45° FOV
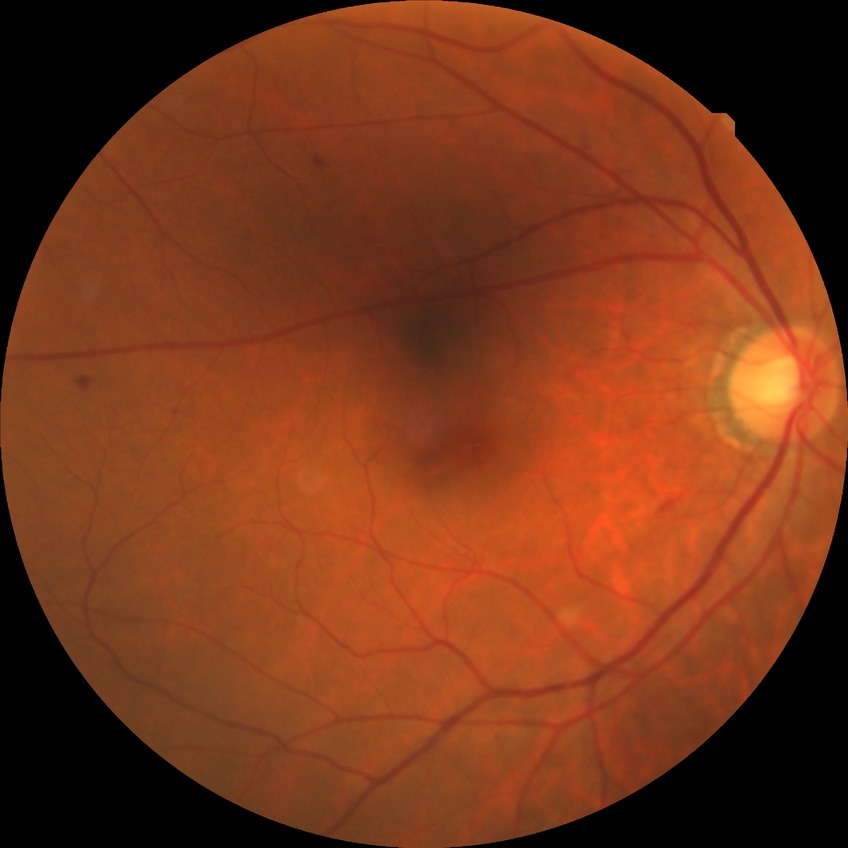

Diabetic retinopathy (DR) is simple diabetic retinopathy (SDR).